Wide-field fundus photograph from neonatal ROP screening.
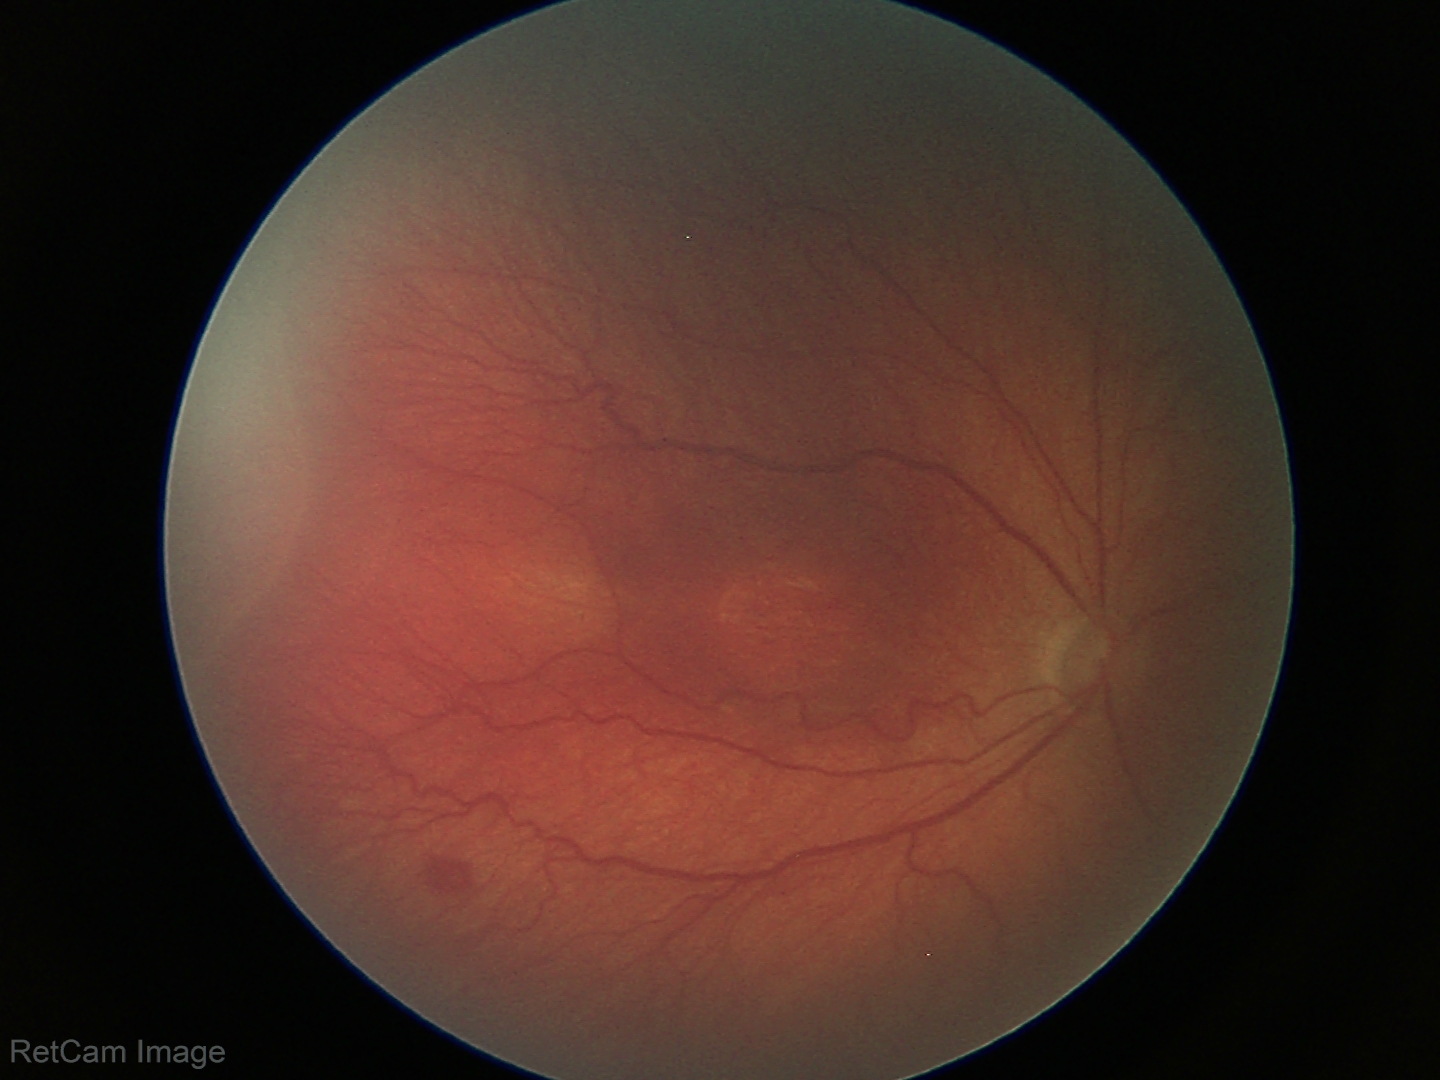
Series diagnosed as ROP stage 3.
No plus disease.